CFP.
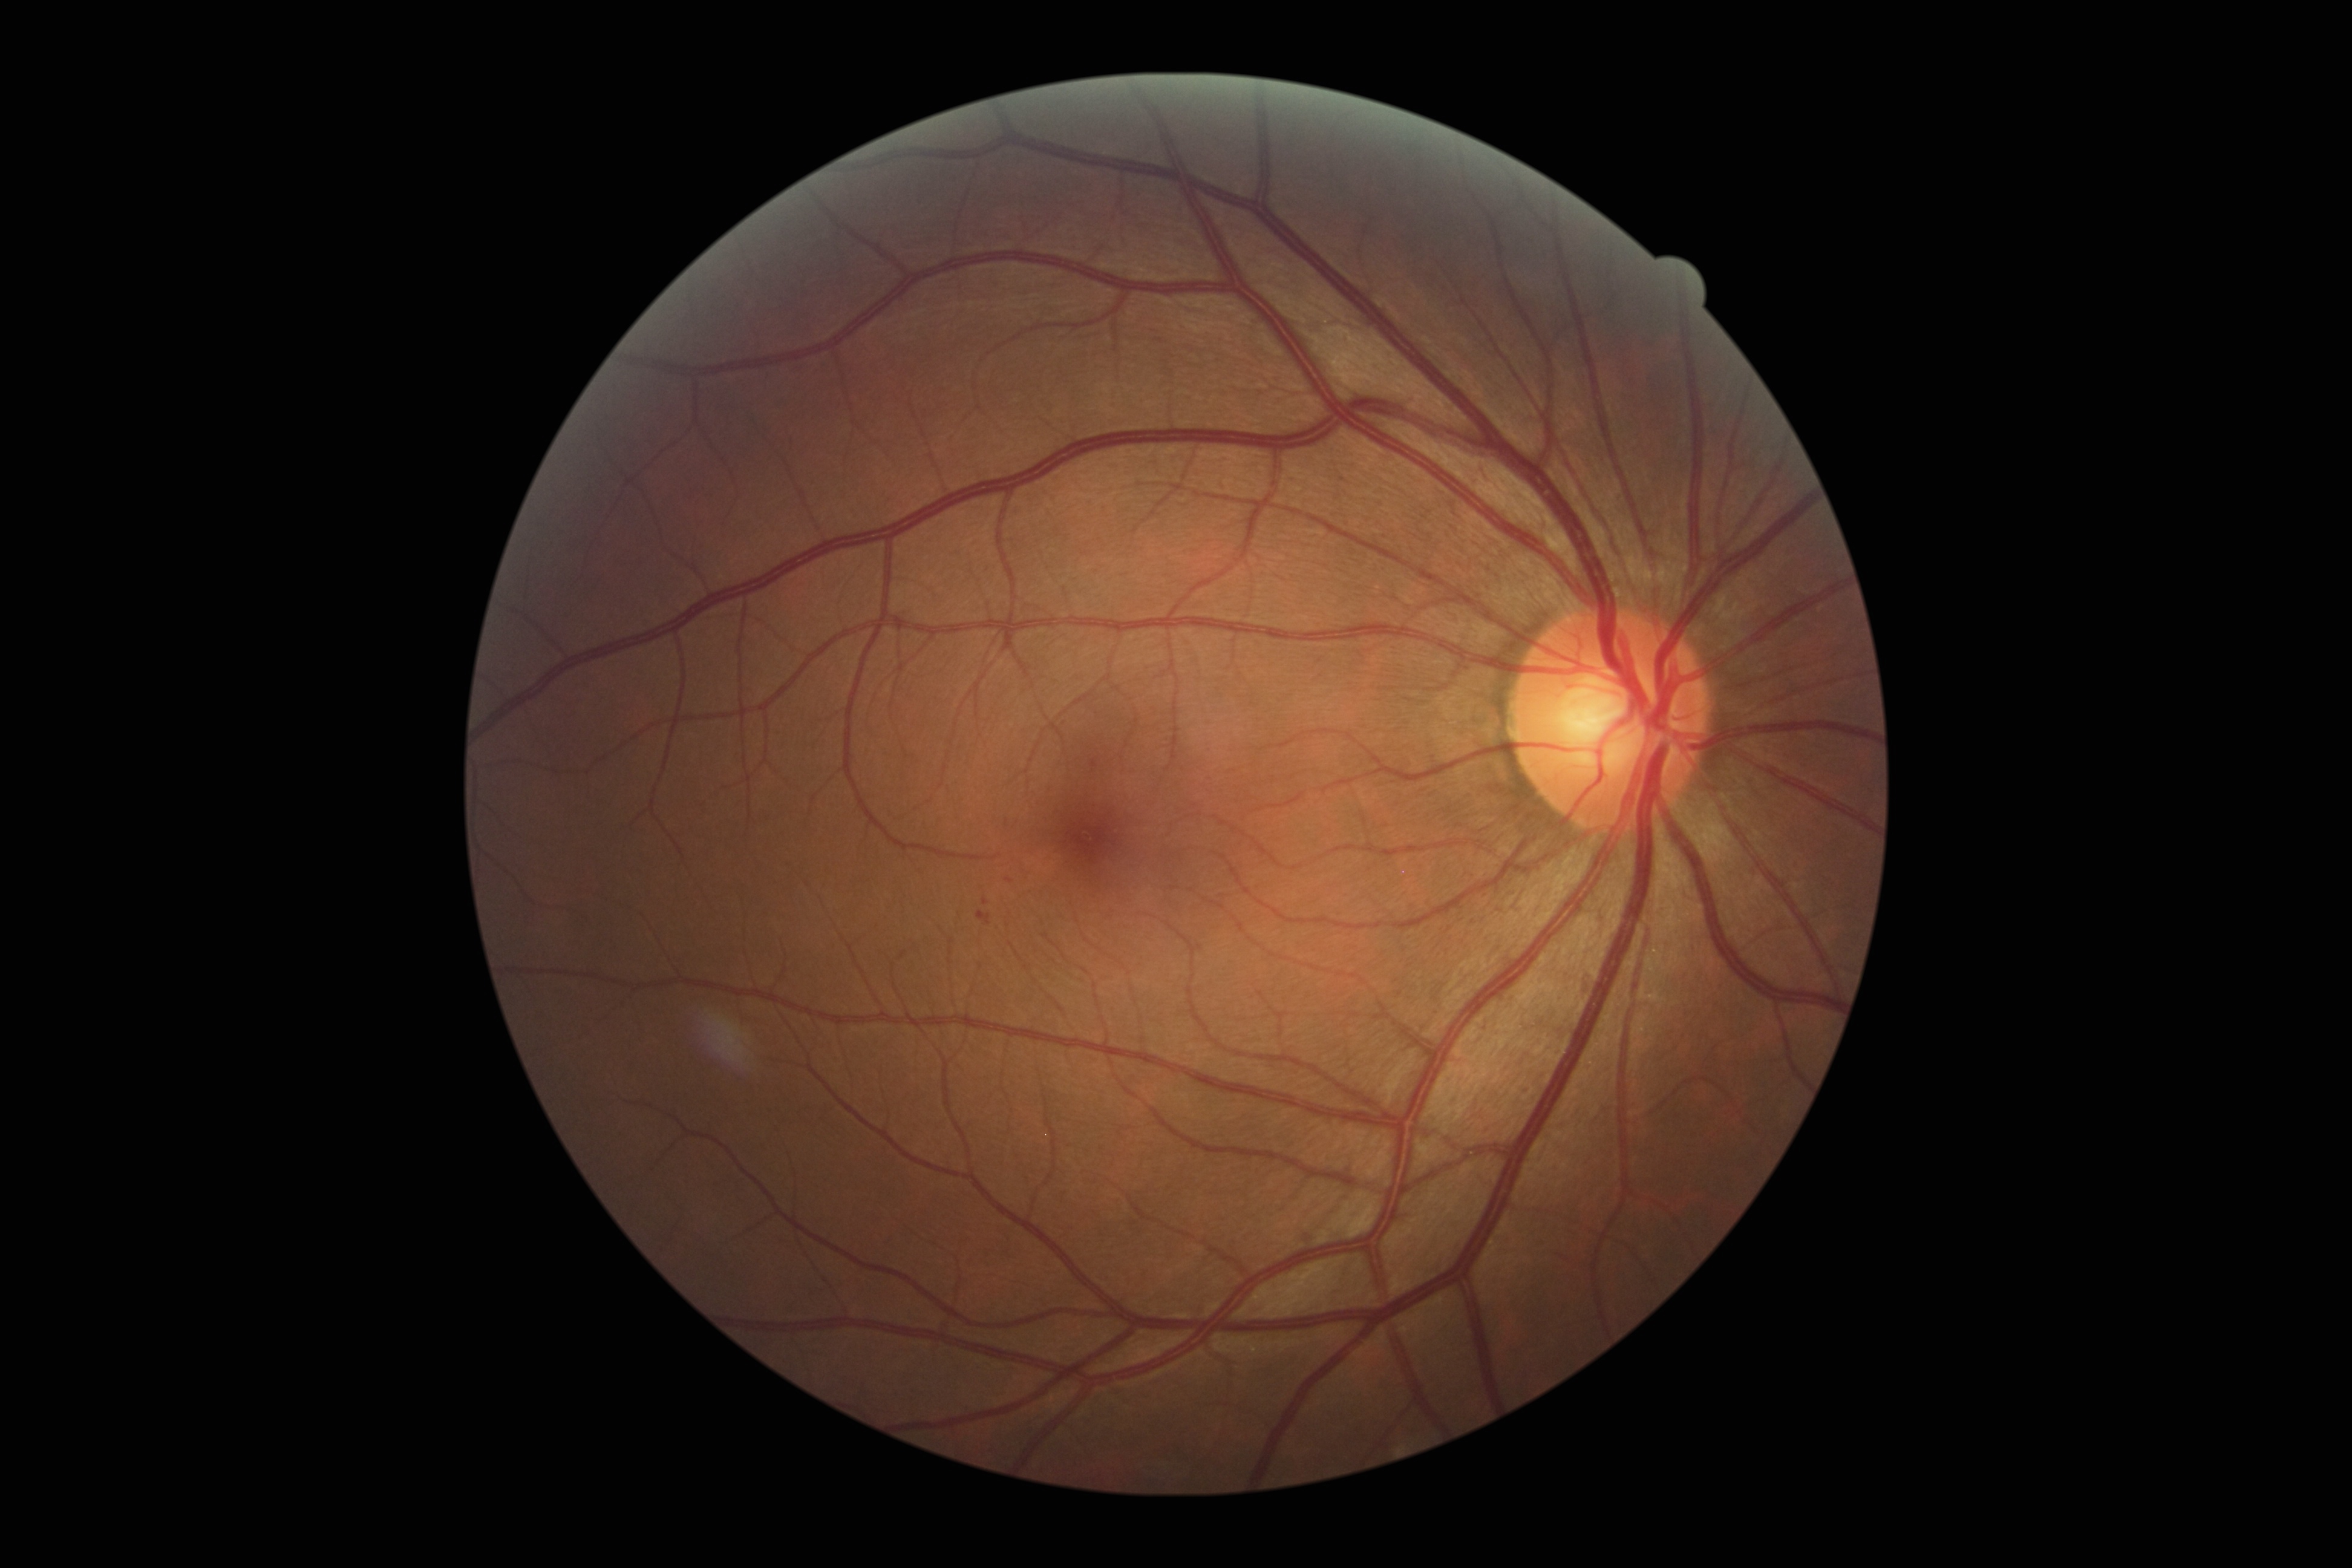

Diabetic retinopathy (DR) is grade 1. No hard exudates (EXs) identified. Microaneurysms (MAs) include 977:912:991:926 | 1092:759:1098:769 | 983:898:989:906. Small MAs near <point>1010, 881</point>. No soft exudates (SEs) identified. No hemorrhages (HEs) identified.